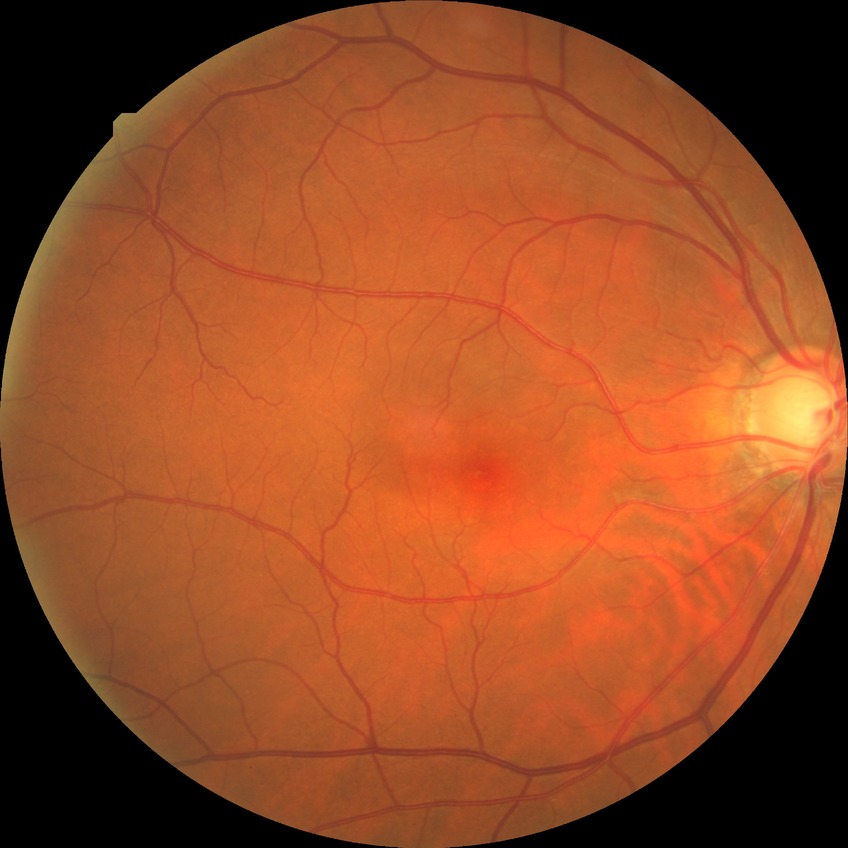
diabetic retinopathy severity: no diabetic retinopathy.